Fundus photo. 45° field of view. 1932 x 1932 pixels:
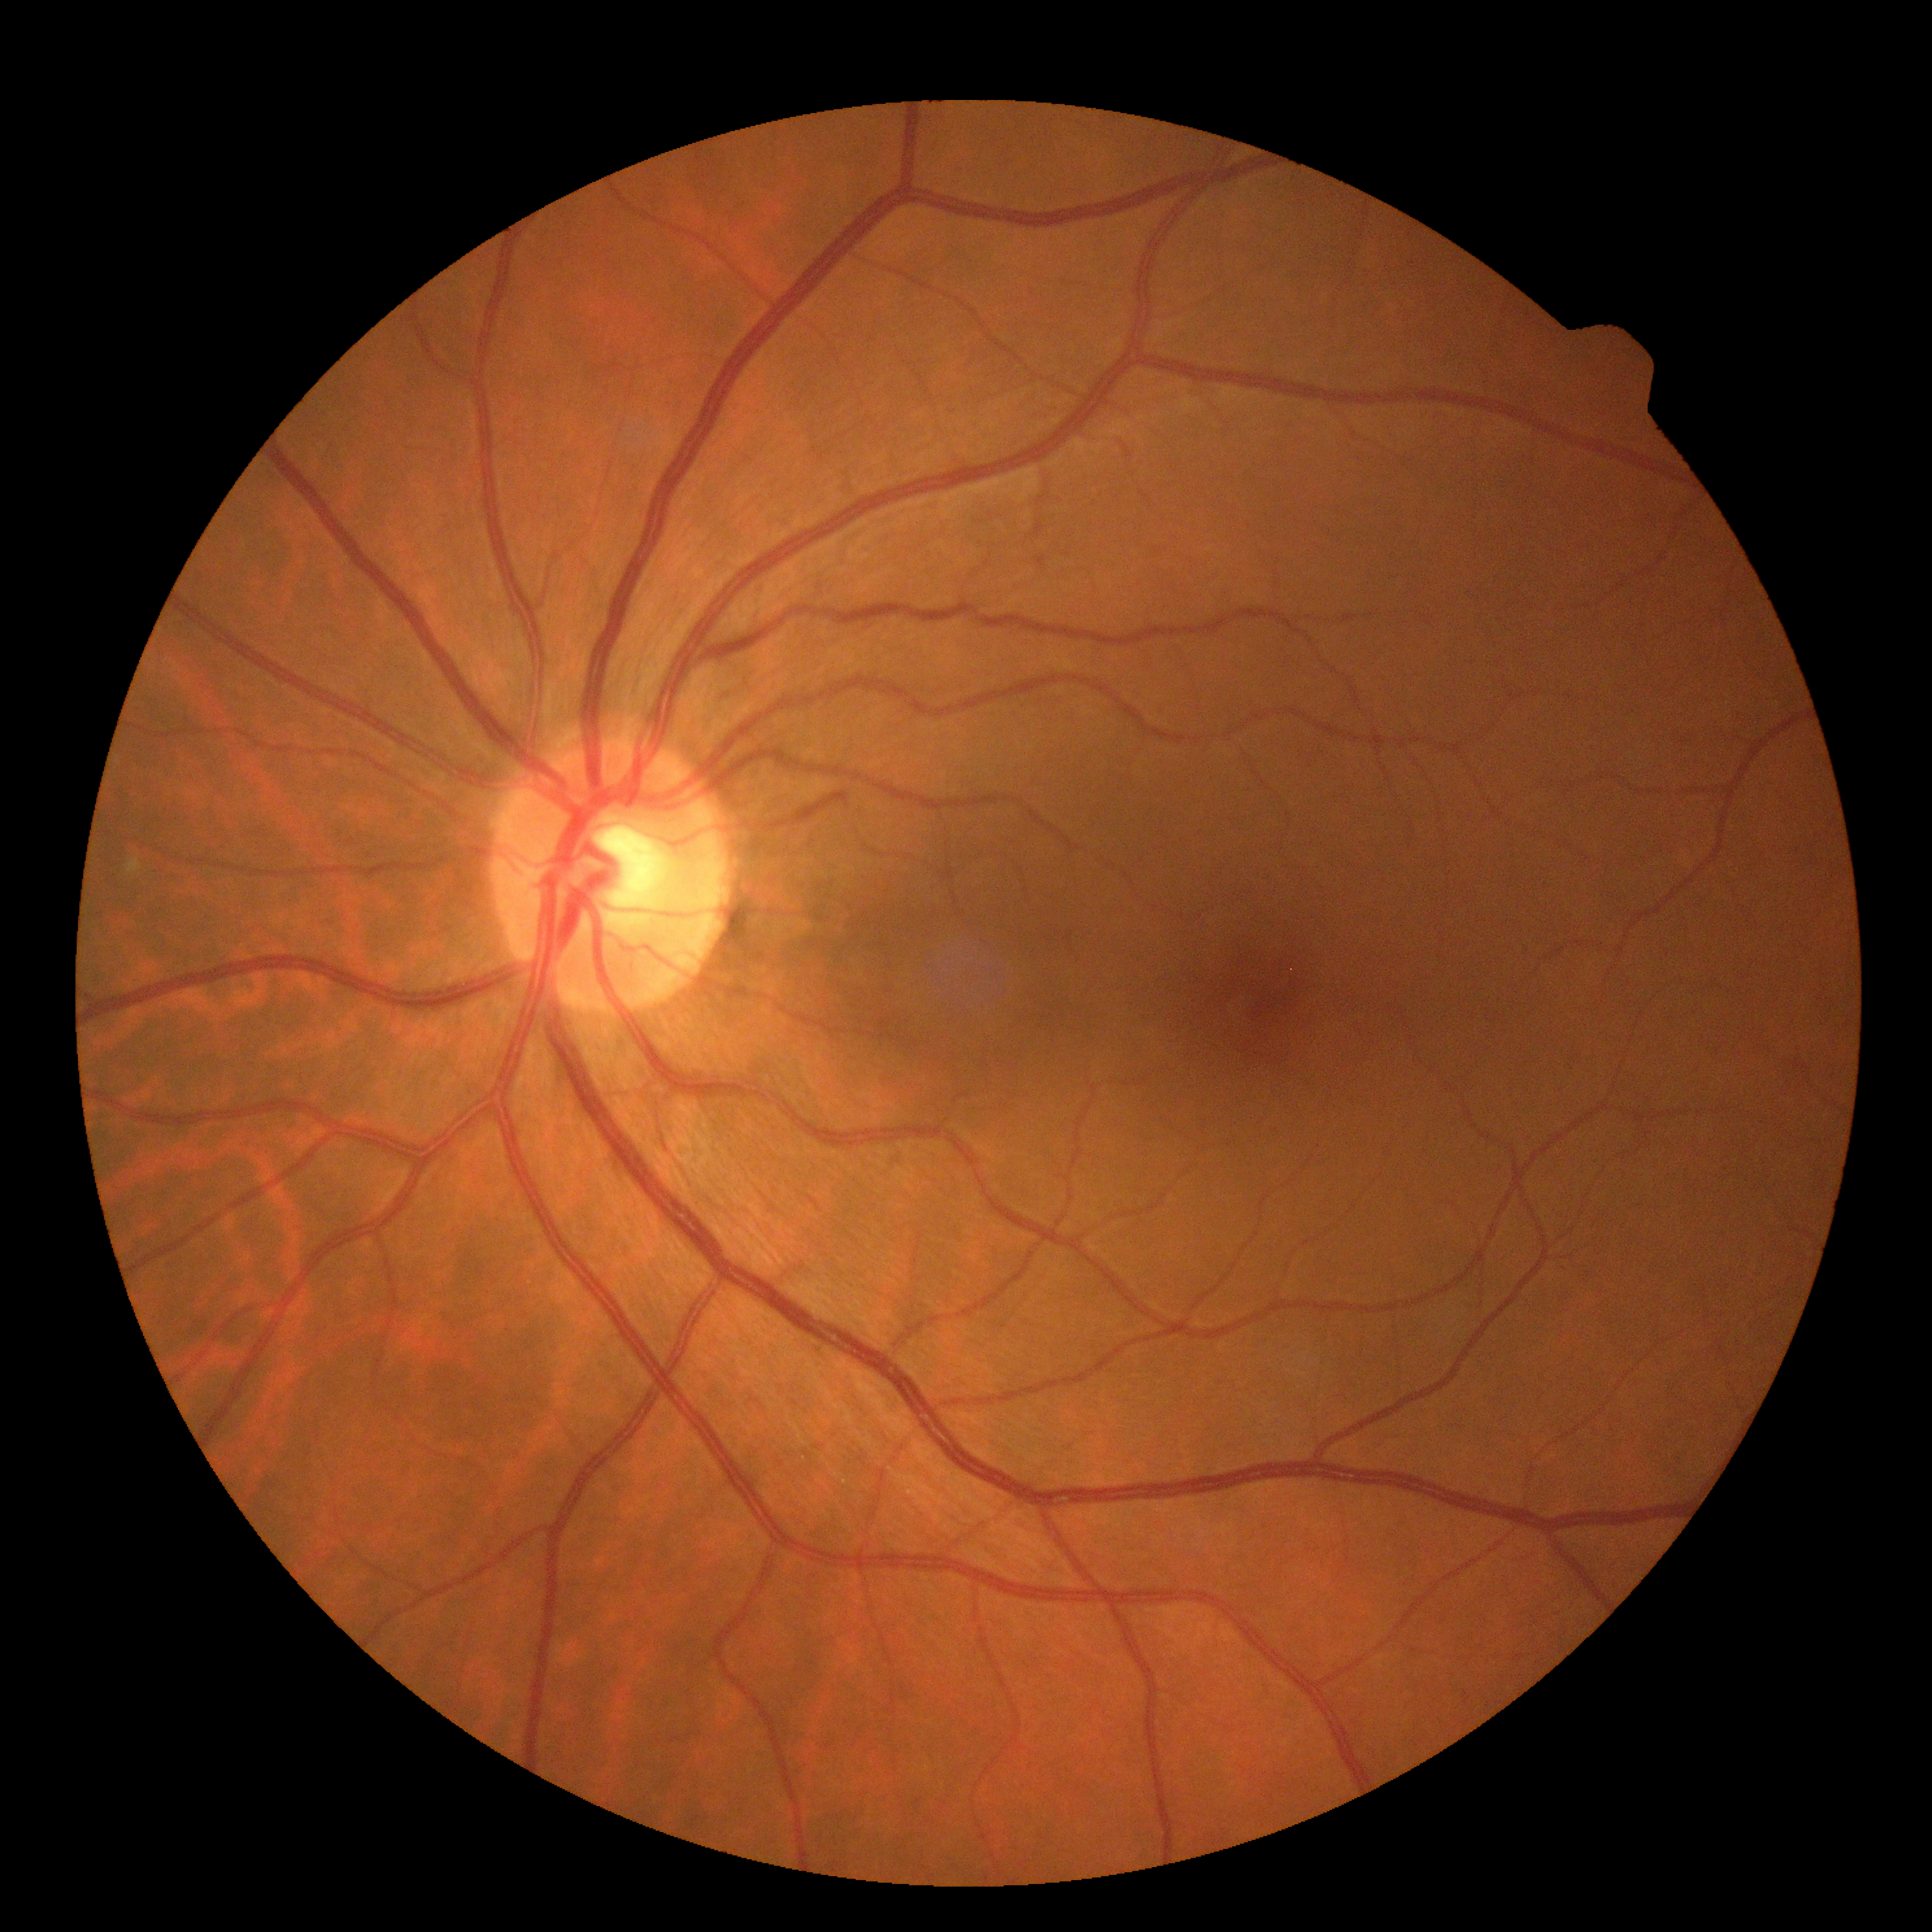

No DR findings. Diabetic retinopathy severity is no apparent diabetic retinopathy (grade 0).